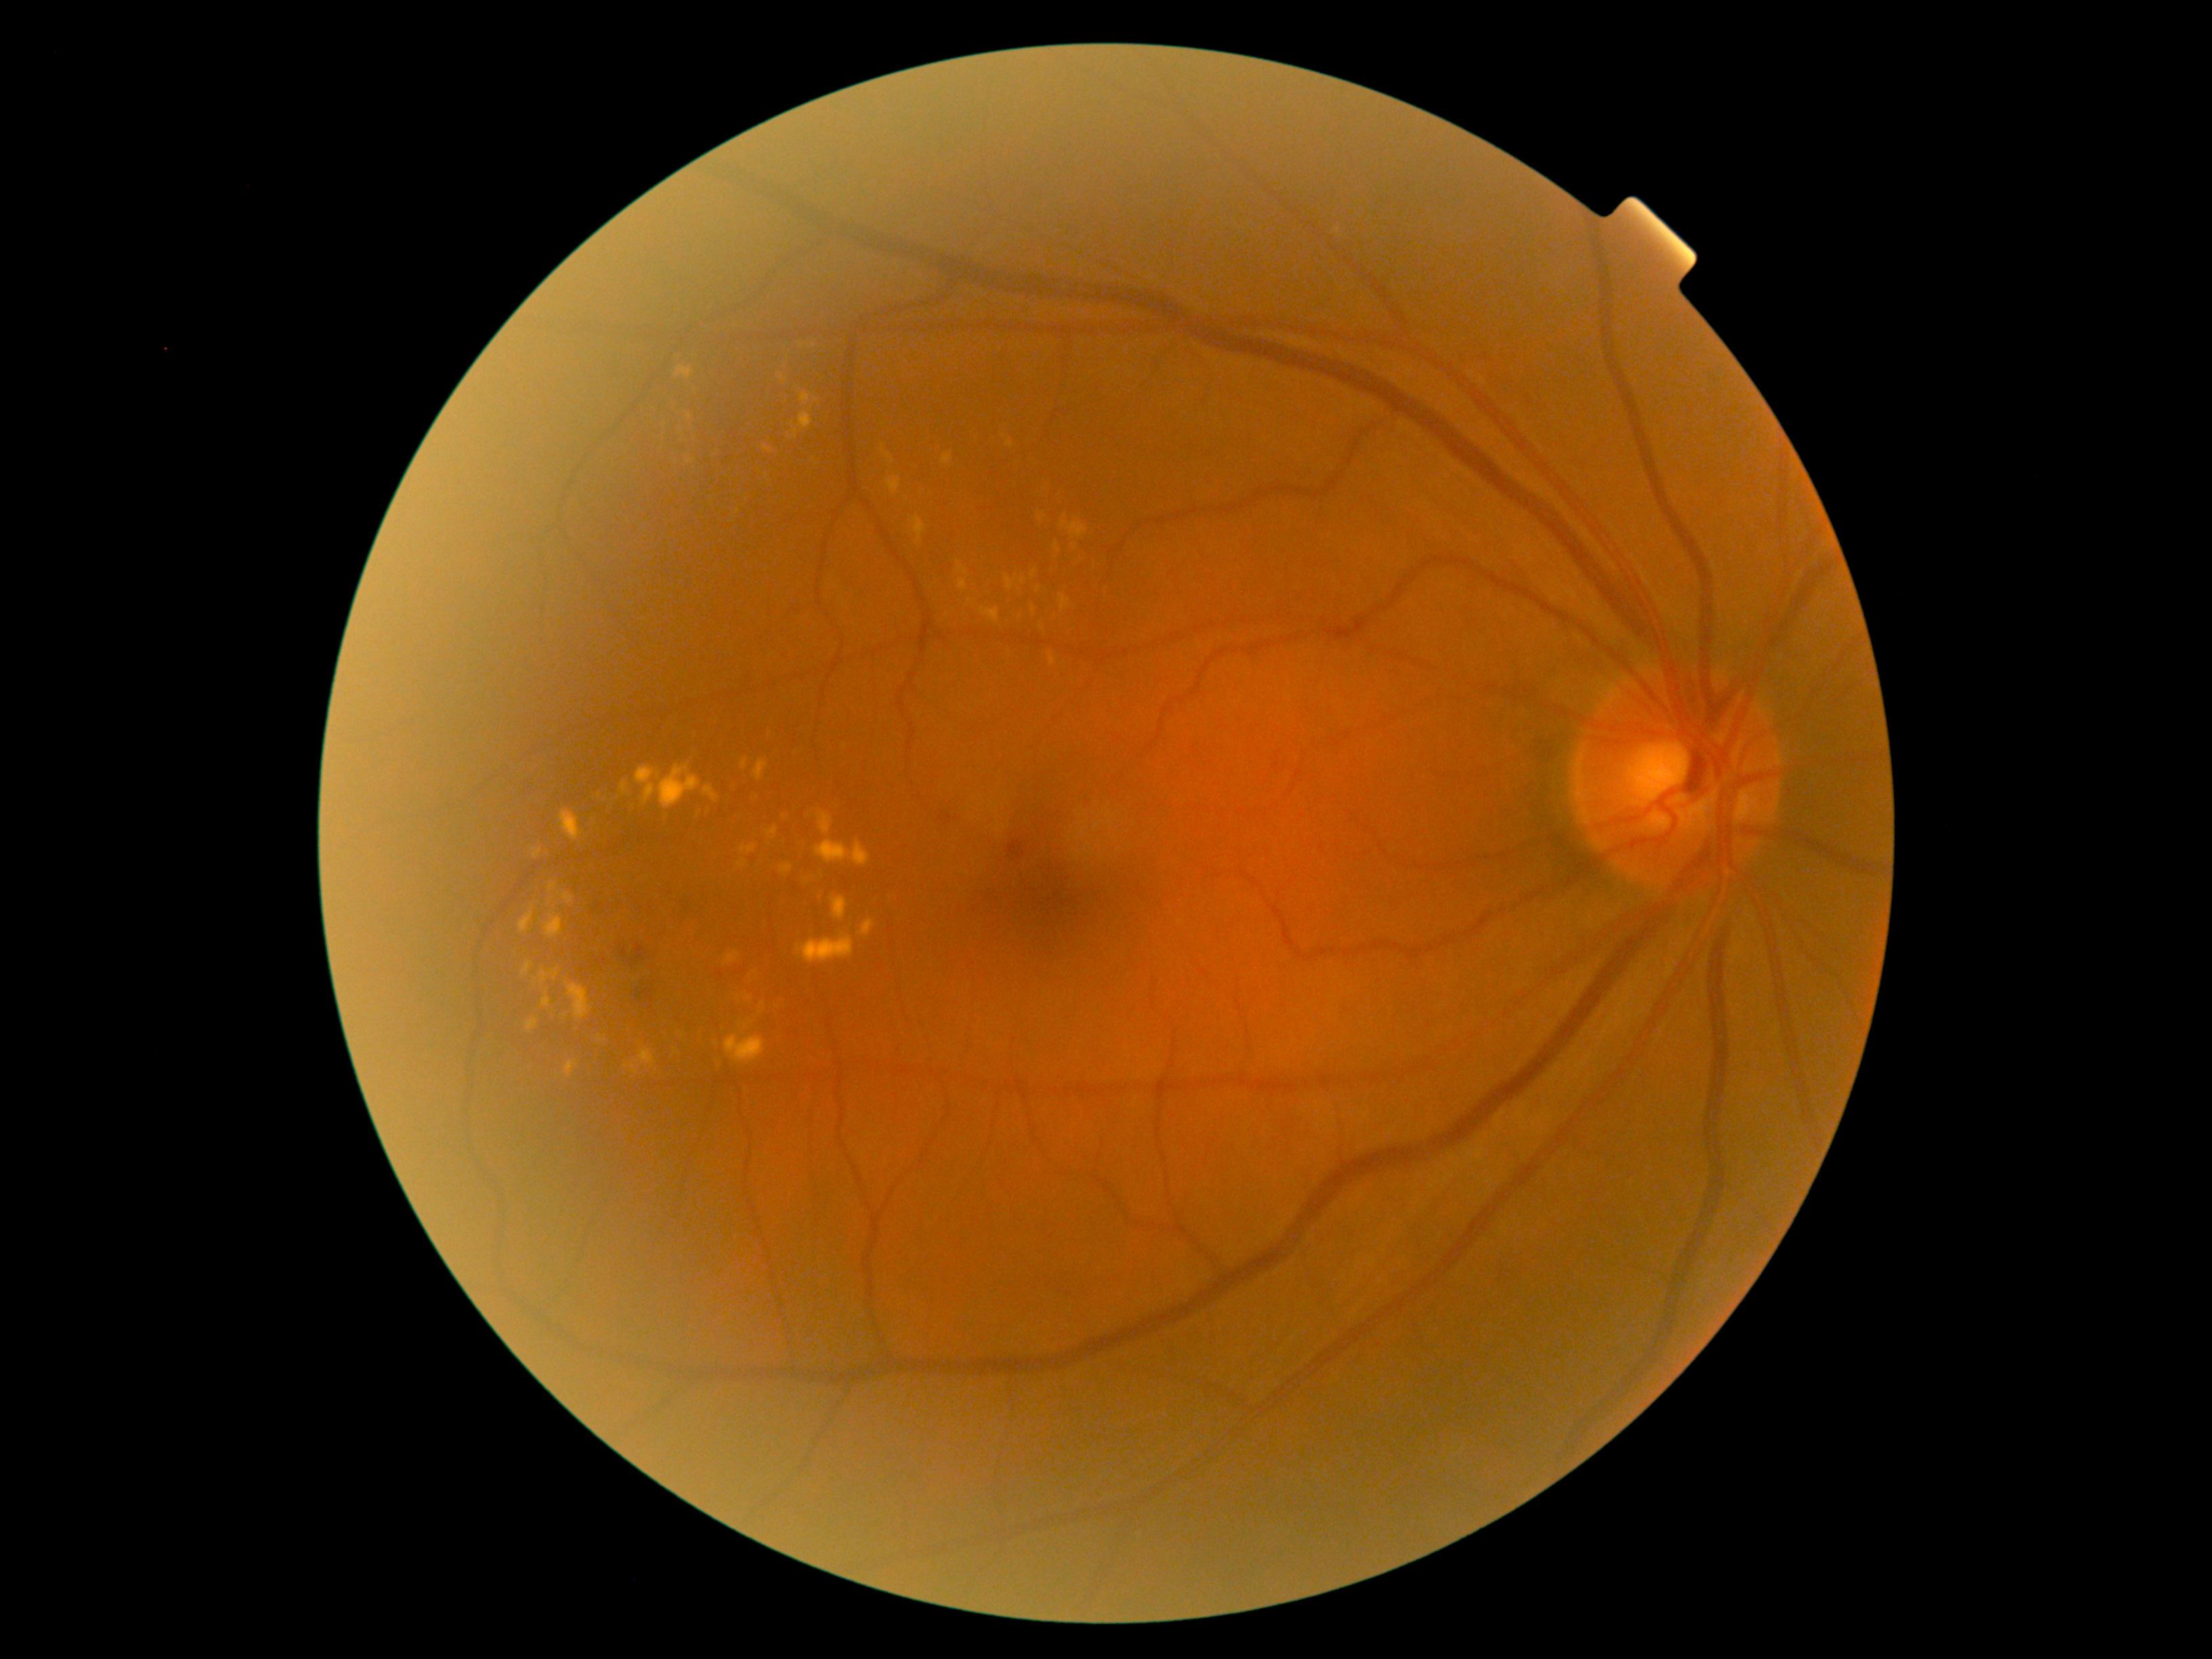 DR grade: 2 (moderate NPDR) — more than just microaneurysms but less than severe NPDR. EXs include [724, 1035, 765, 1065], [880, 445, 894, 464], [621, 781, 630, 795], [742, 758, 747, 769], [696, 804, 701, 819], [1059, 523, 1088, 539], [540, 971, 550, 985], [1032, 570, 1038, 579], [1032, 607, 1035, 615], [533, 849, 543, 859], [943, 452, 954, 466], [819, 814, 833, 836], [958, 562, 968, 577], [1059, 594, 1070, 613], [520, 910, 533, 933]. Small EXs near pt(1044, 515), pt(1022, 580), pt(816, 400), pt(783, 379).